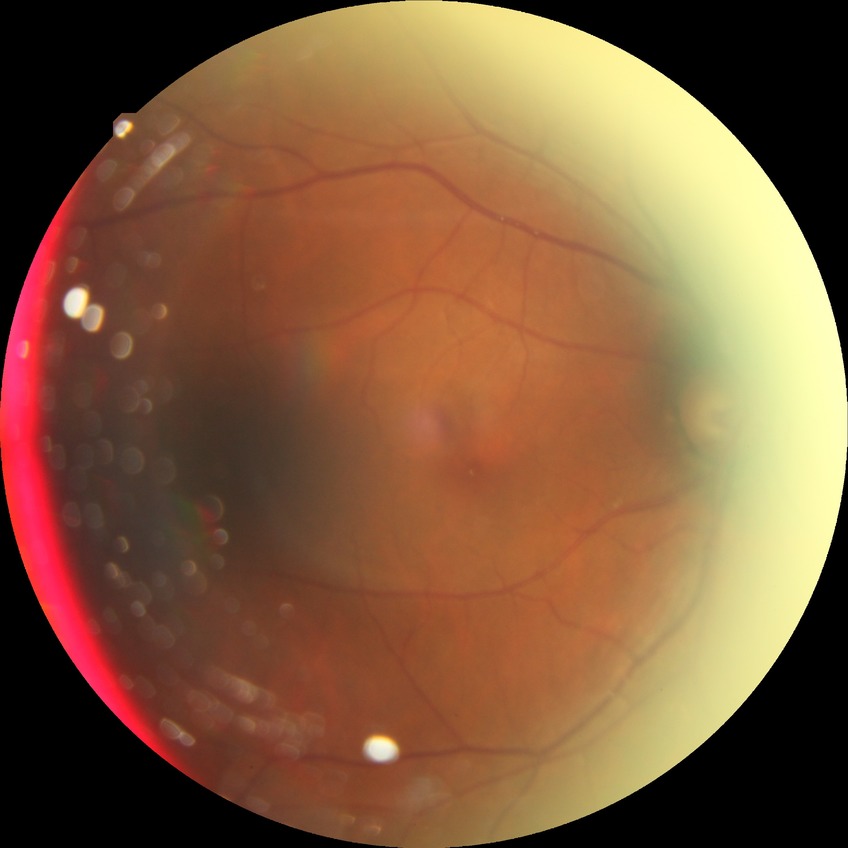
diabetic retinopathy (DR): no diabetic retinopathy (NDR).